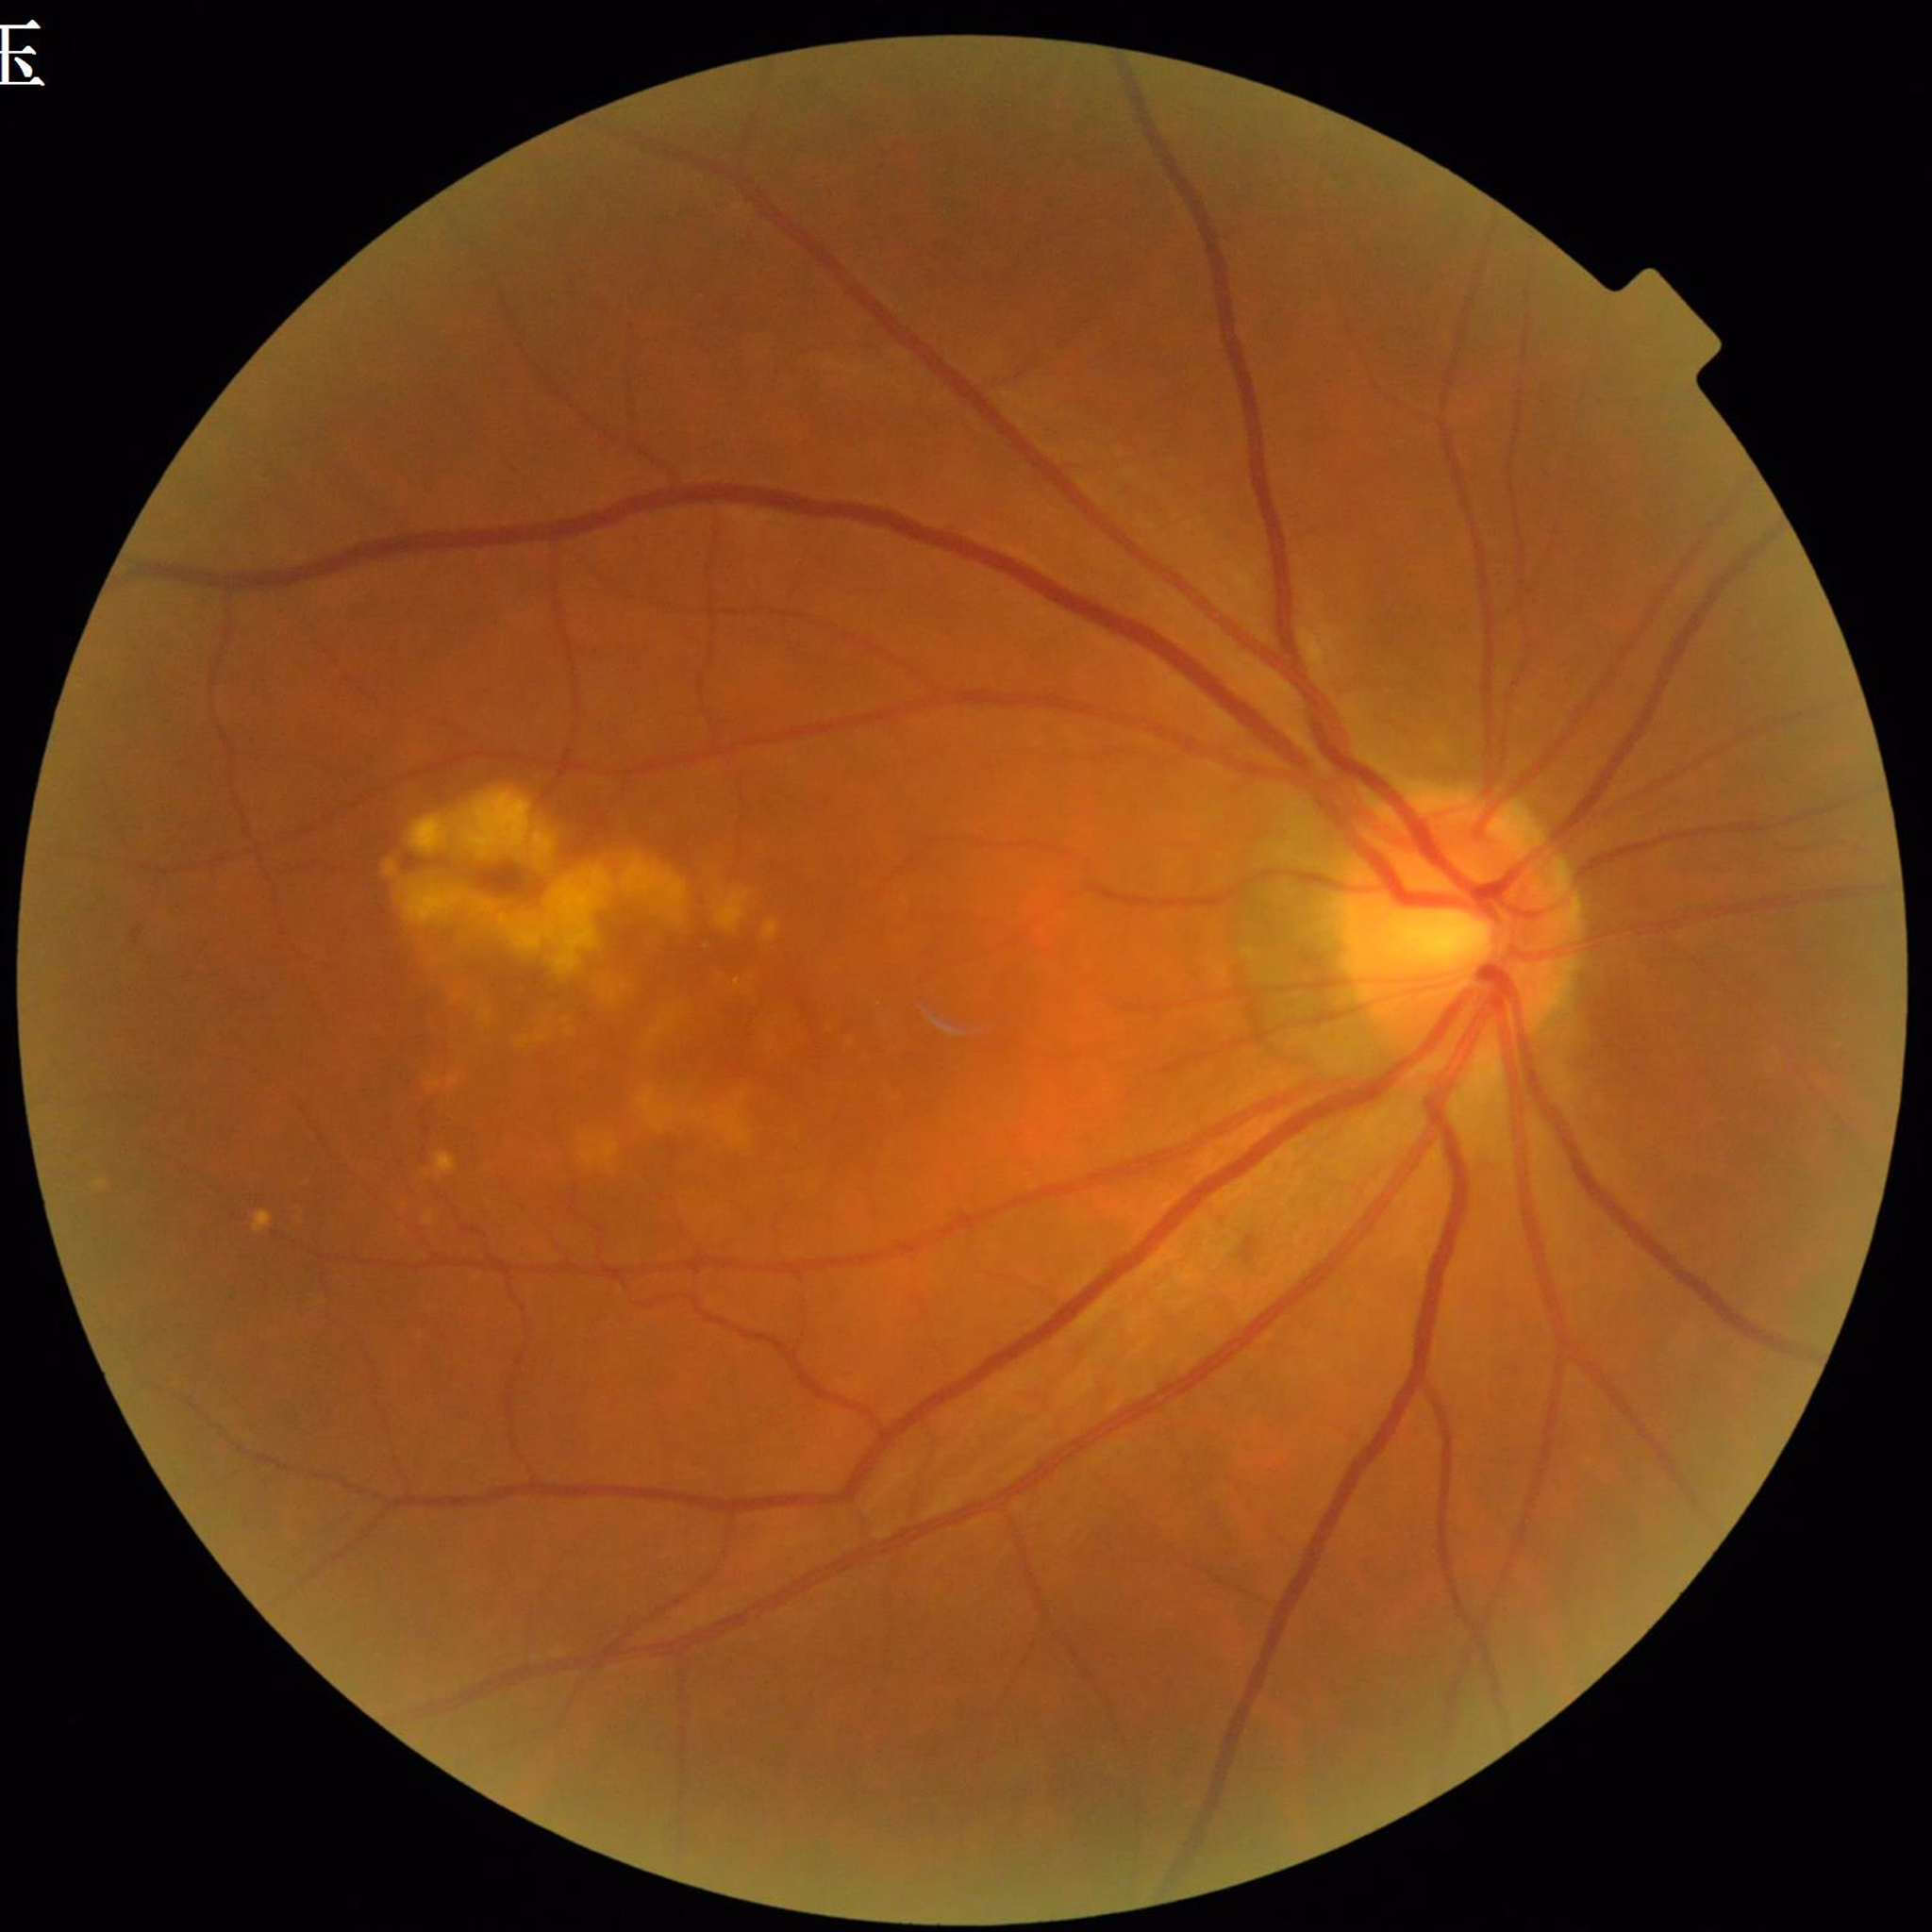 Quality: contrast adequate, no blur, illumination and color satisfactory. Fundus image of an eye with age-related macular degeneration.